Centered on the optic disc
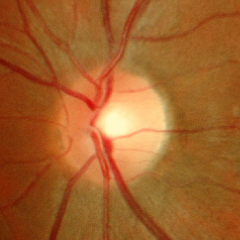 No glaucomatous findings.